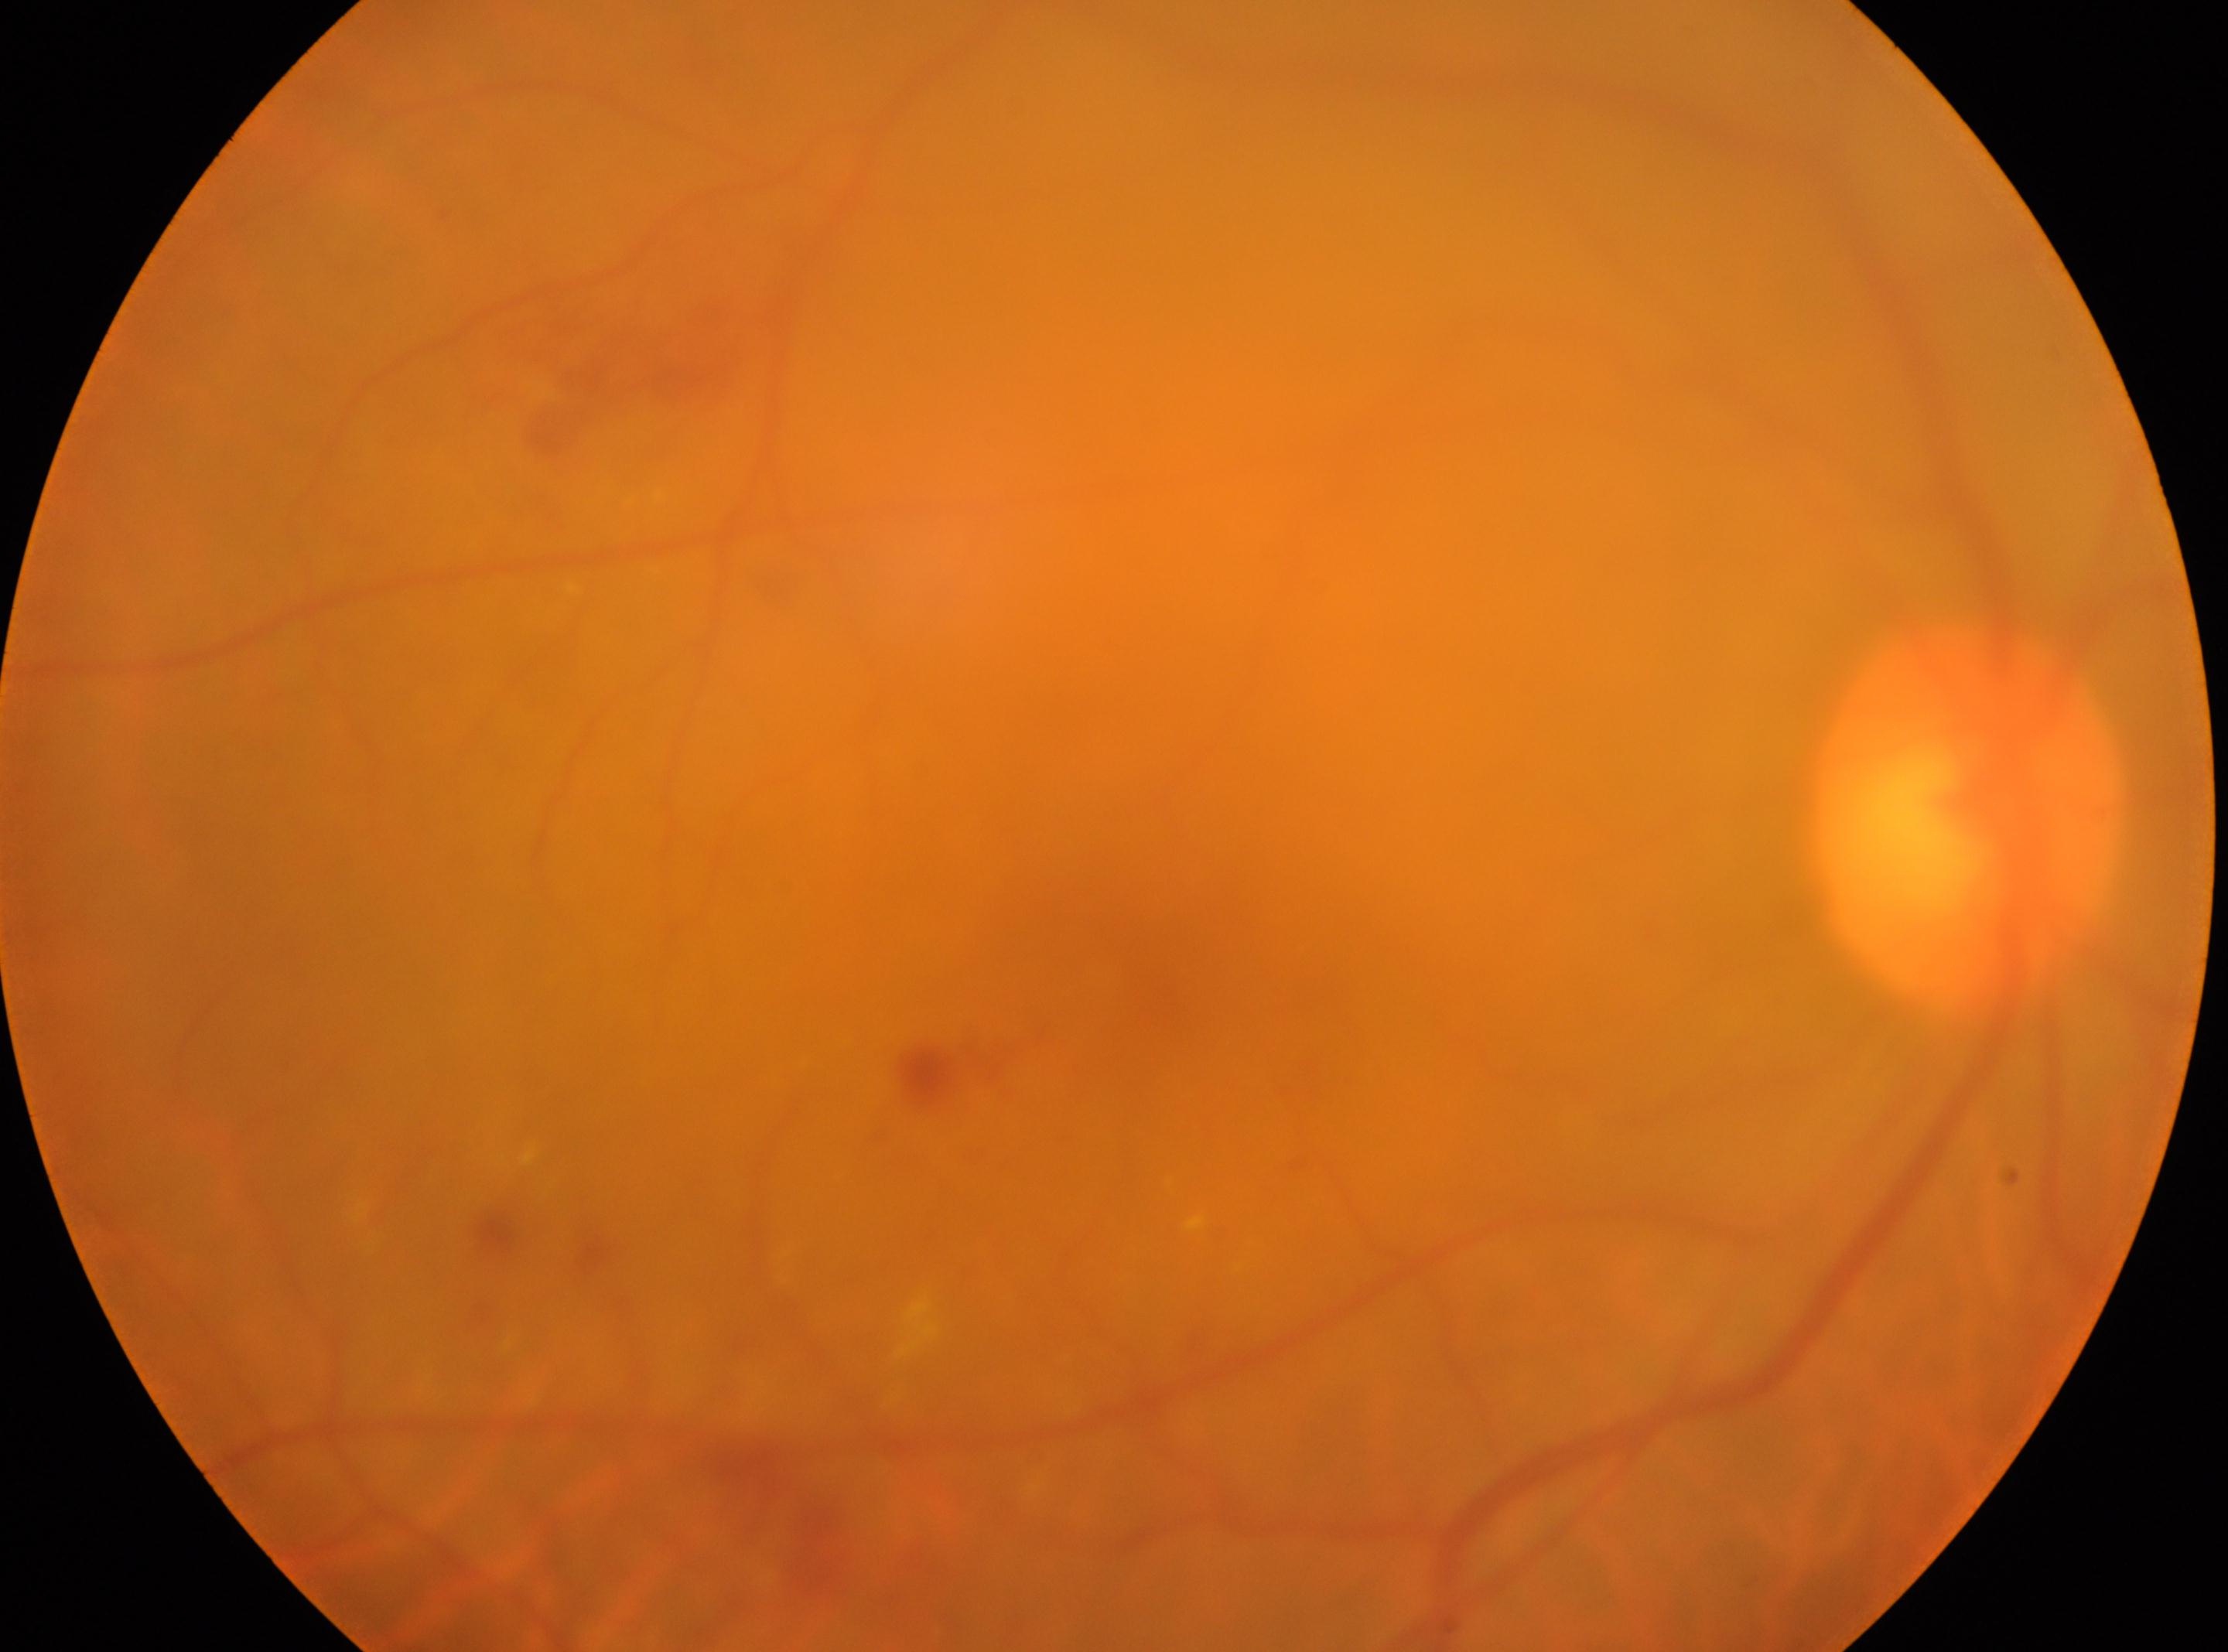

– macular center · (1160,970)
– DR class · non-proliferative diabetic retinopathy
– laterality · right
– optic disk · (1965,818)
– diabetic retinopathy grade · 2/4